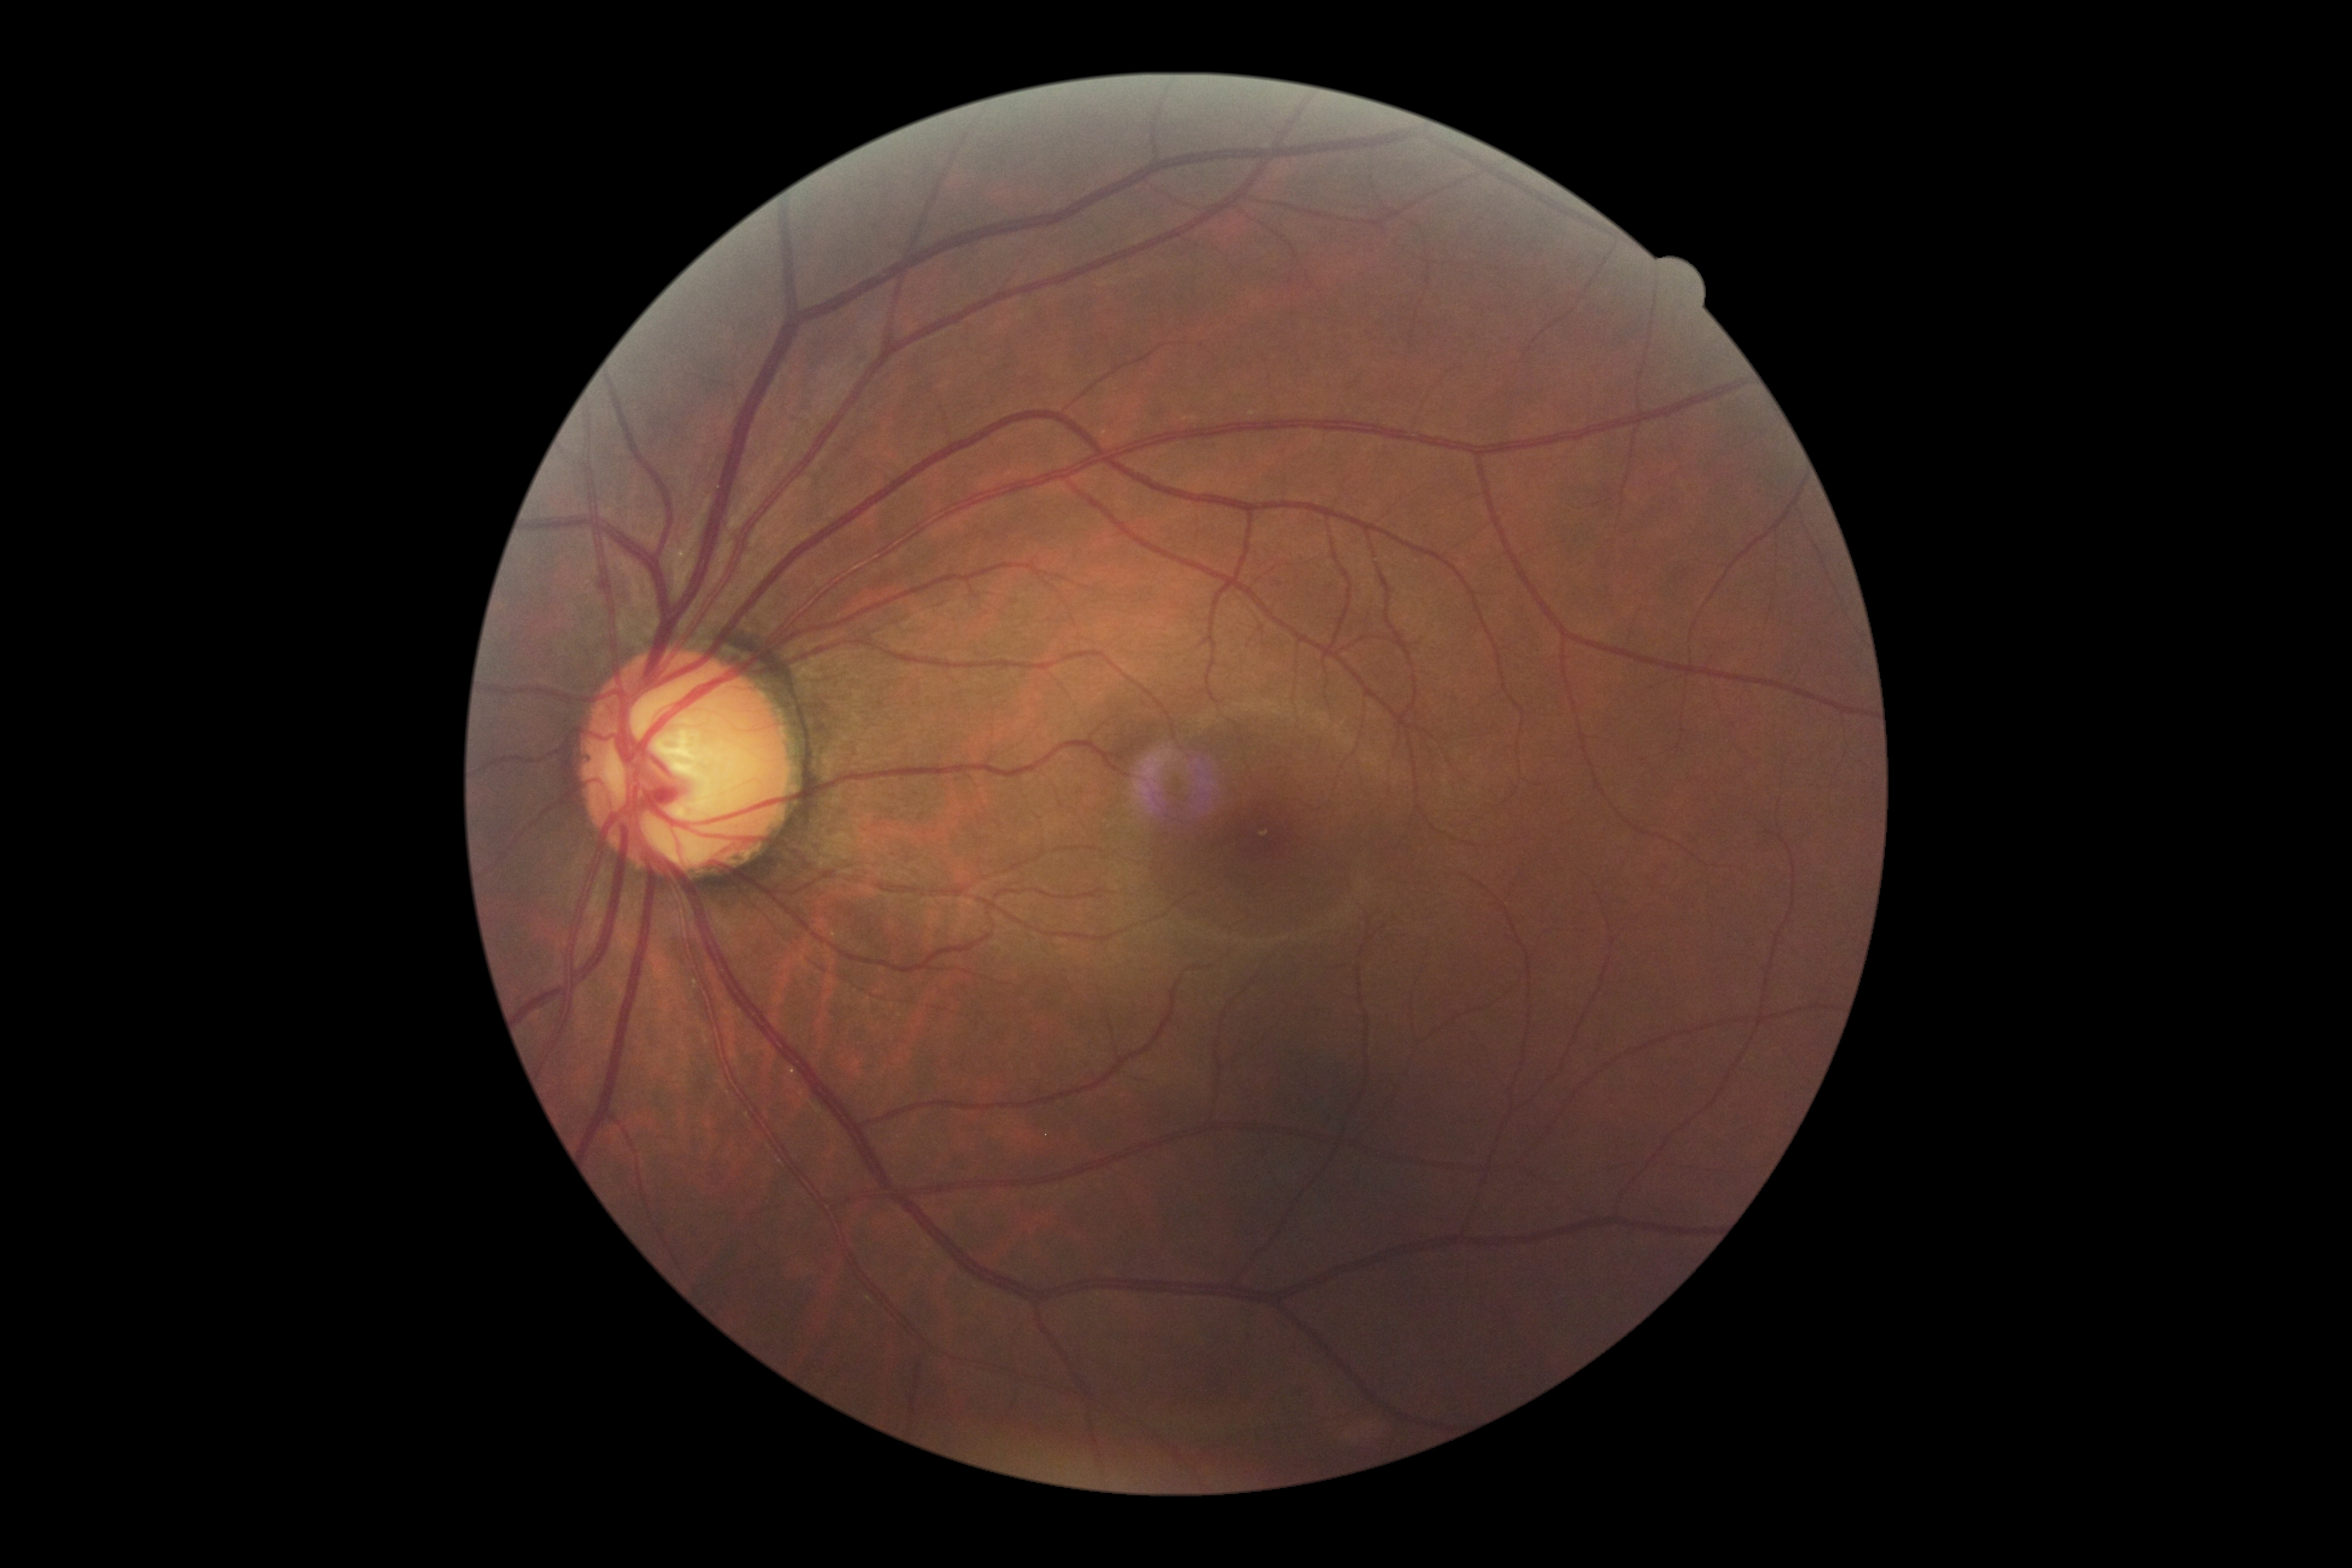 Retinopathy grade: no apparent retinopathy (0).